Posterior pole field covering the optic disc and macula: 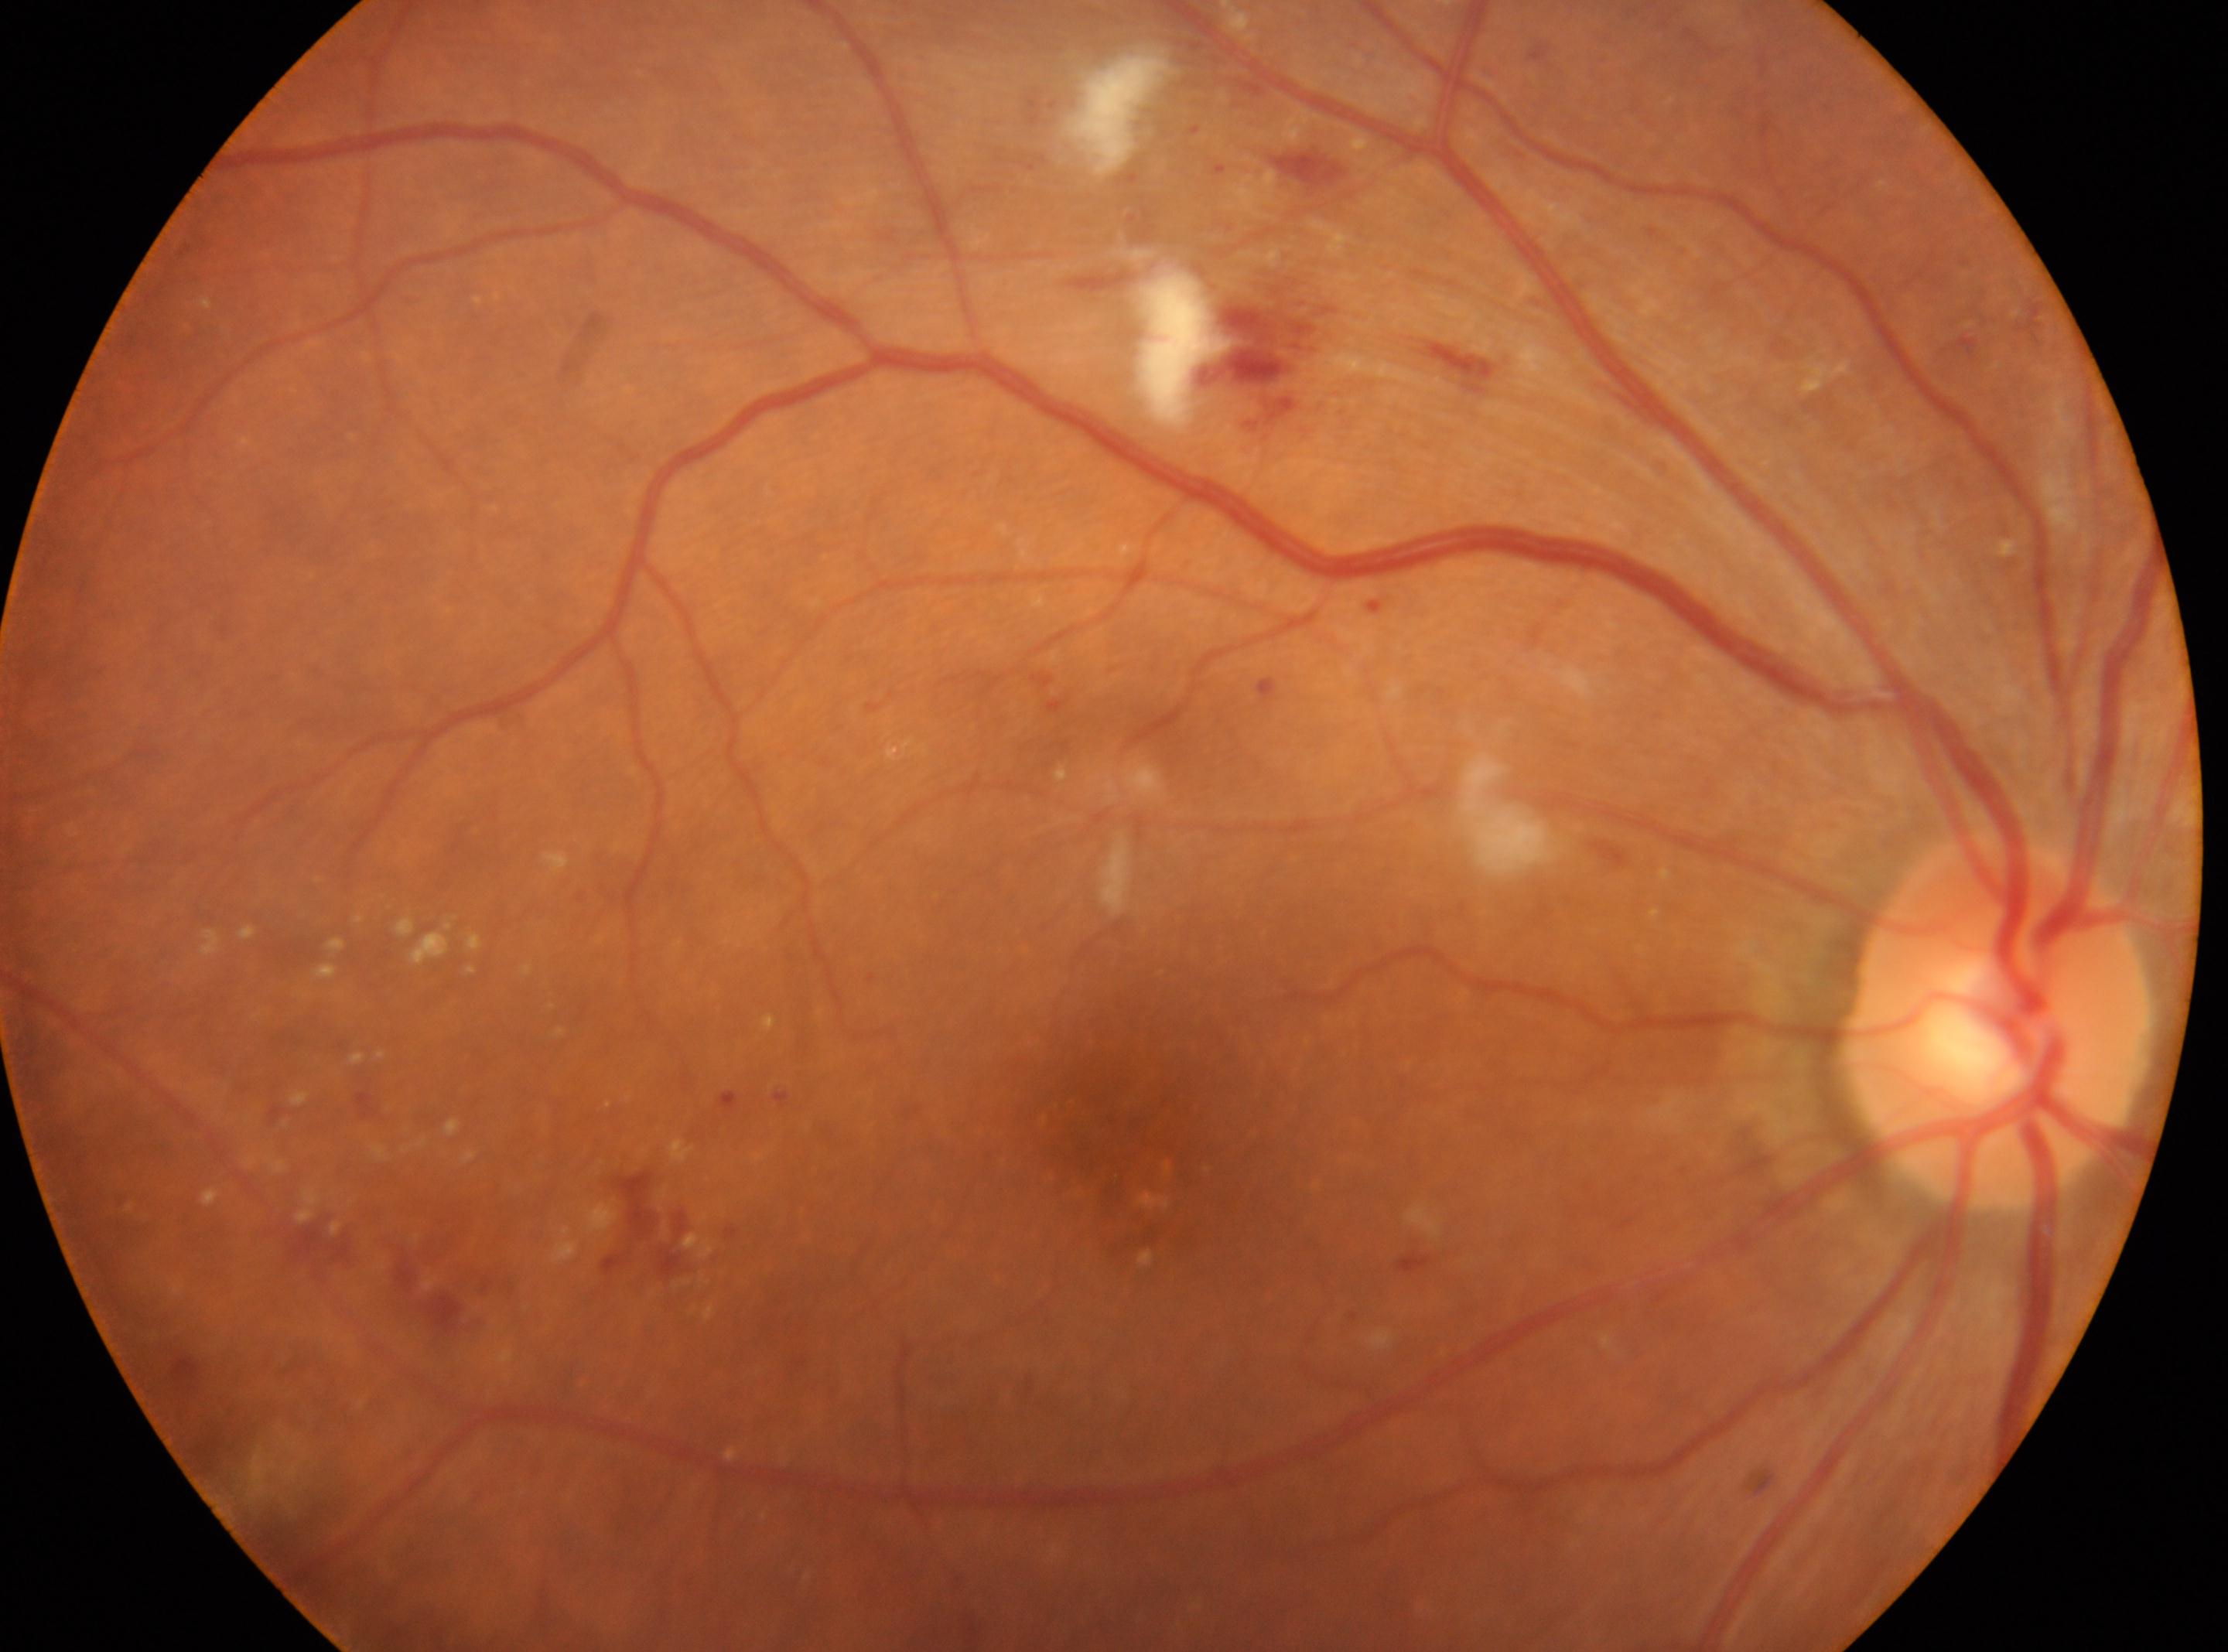
  fovea: 1123px, 1132px
  dr_category: non-proliferative diabetic retinopathy
  optic_disc: 1991px, 1022px
  dr_grade: 2/4 — more than just microaneurysms but less than severe NPDR
  eye: oculus dexter